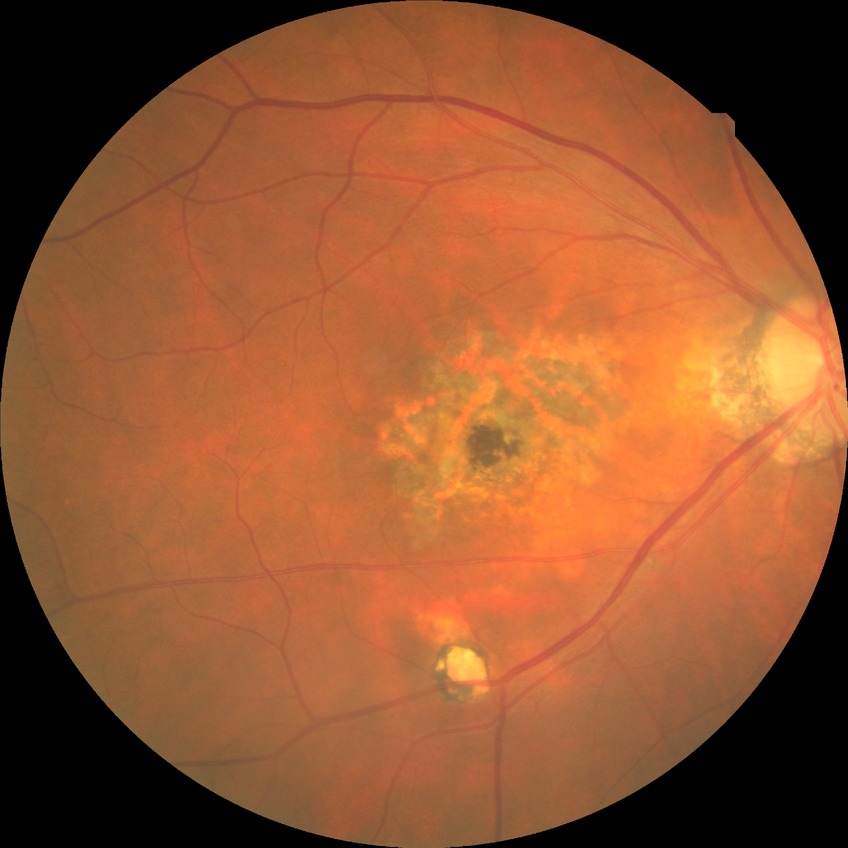

Diabetic retinopathy (DR): no diabetic retinopathy (NDR).